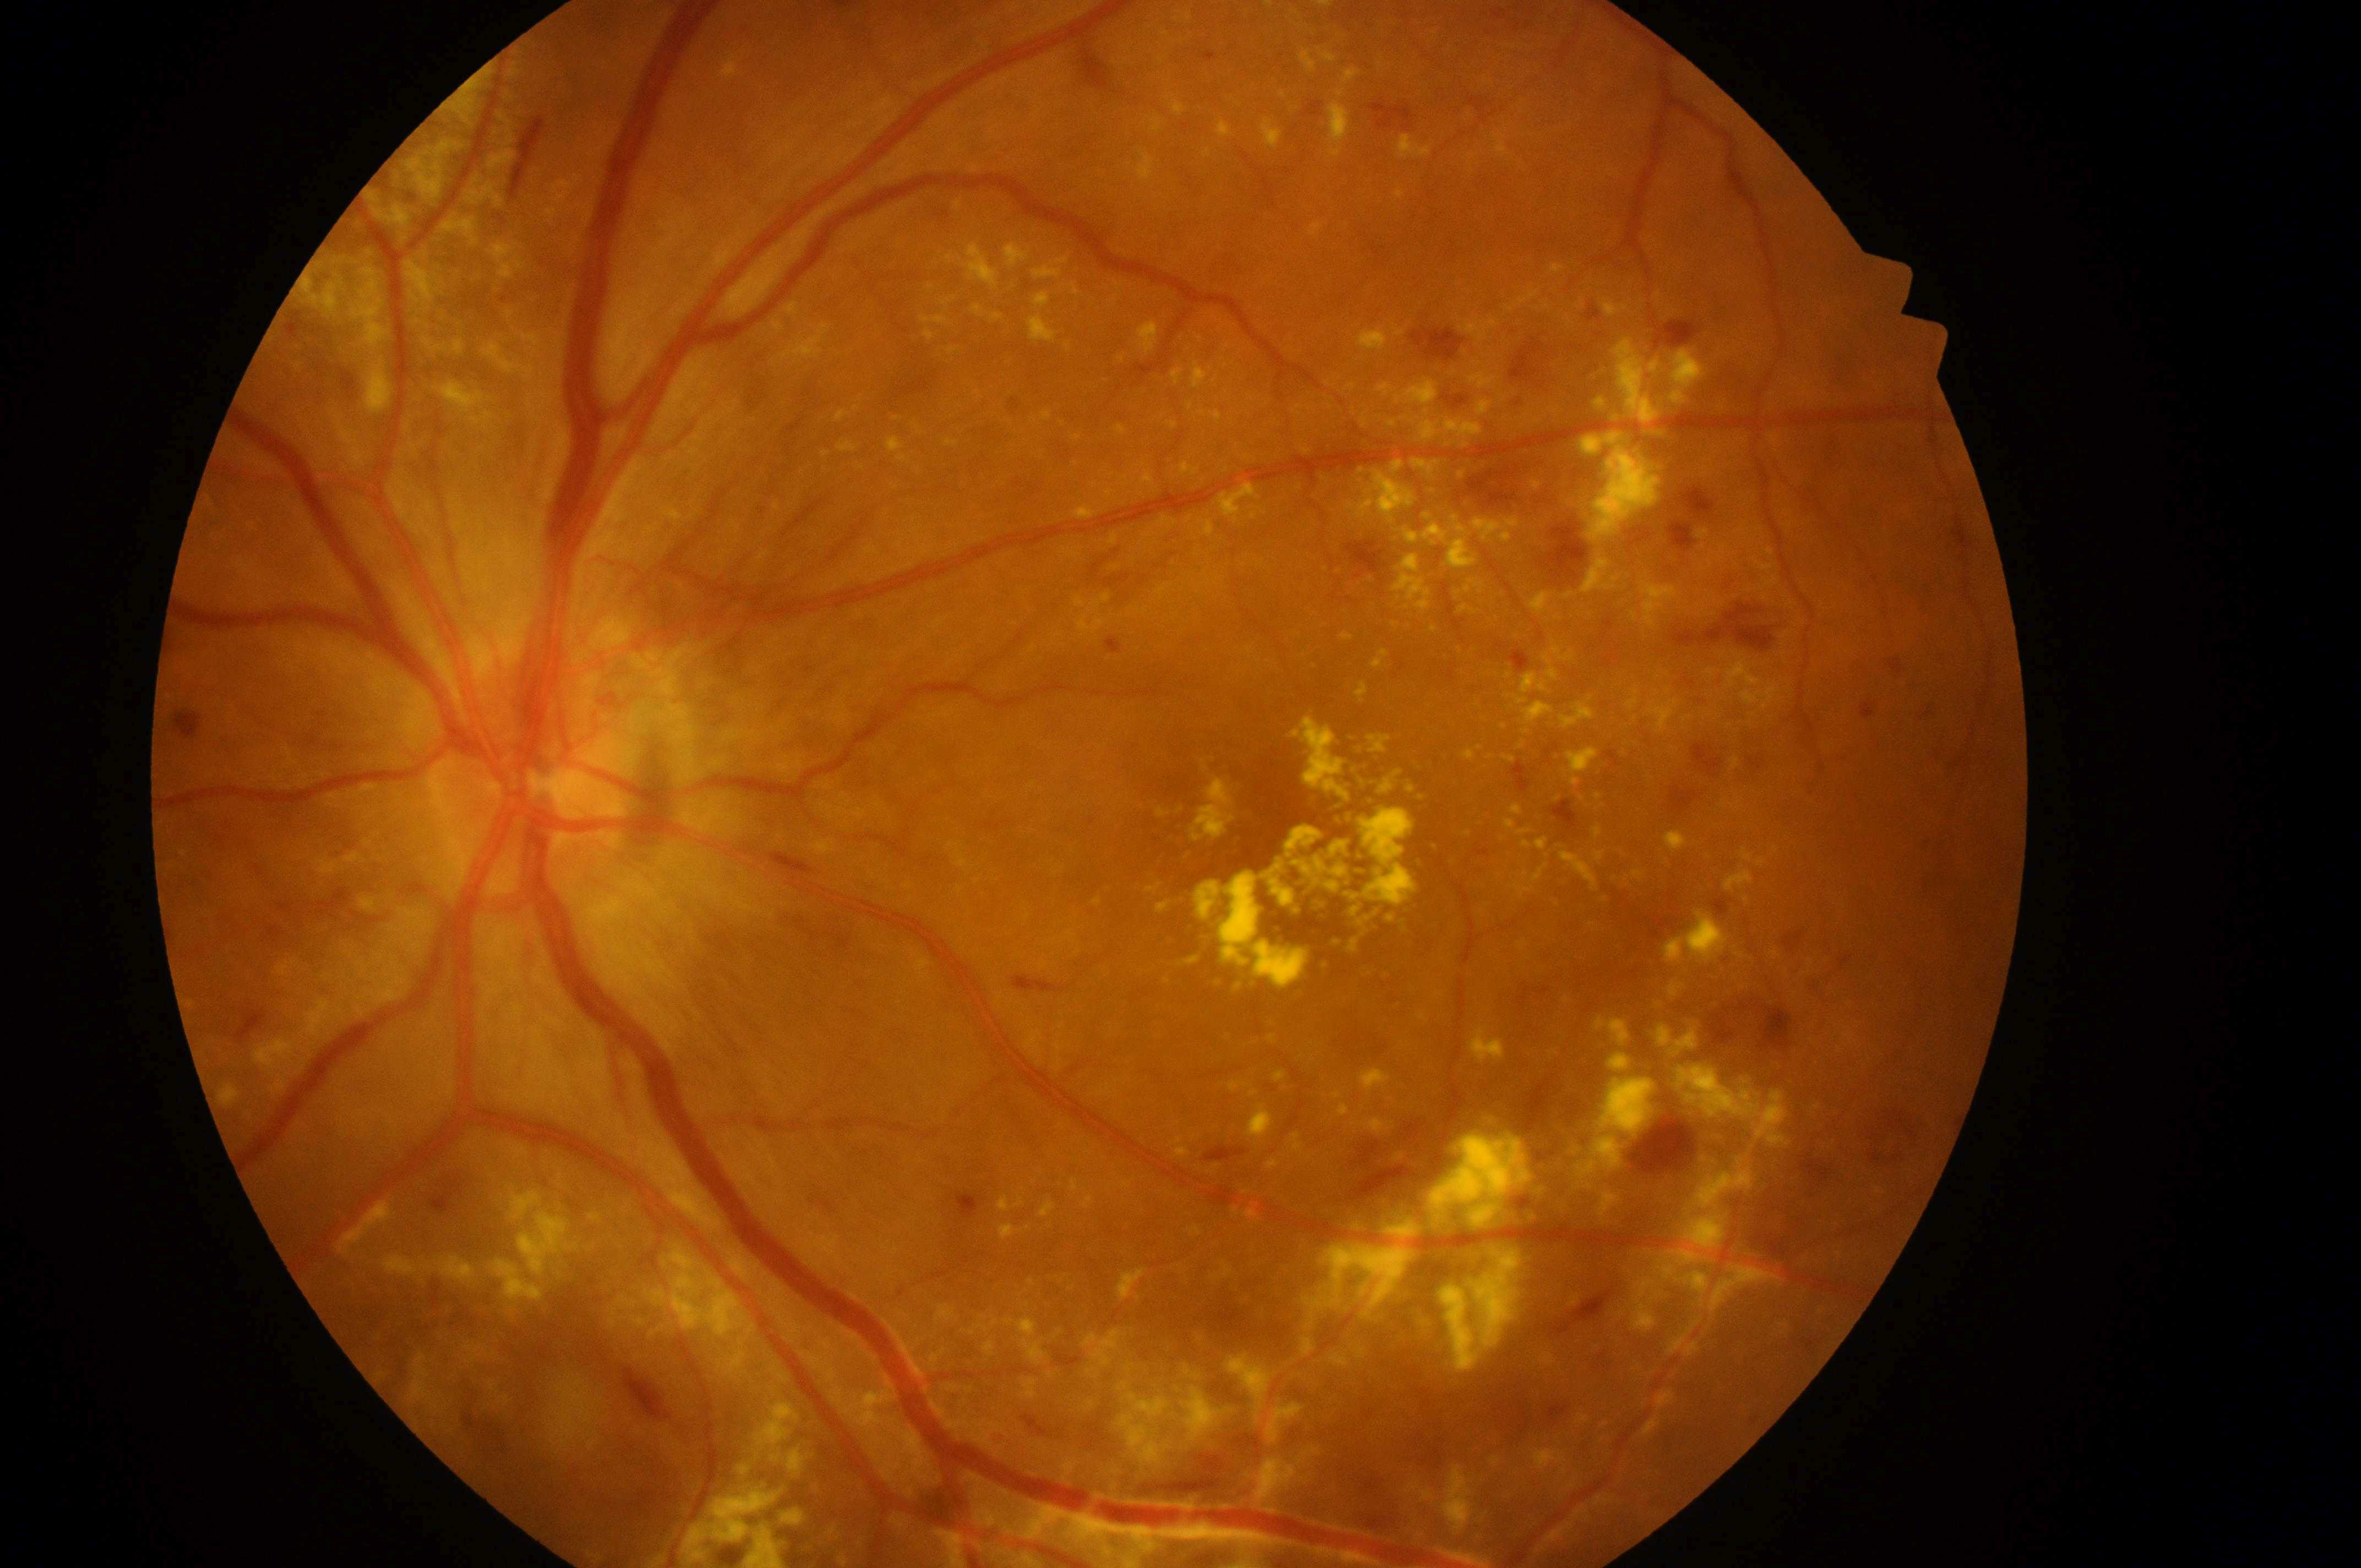
Q: Optic disc center?
A: 546px, 785px
Q: Where is the fovea?
A: 1291px, 835px
Q: DME grade?
A: 2
Q: Diabetic retinopathy severity?
A: grade 4
Q: What is the laterality?
A: OS